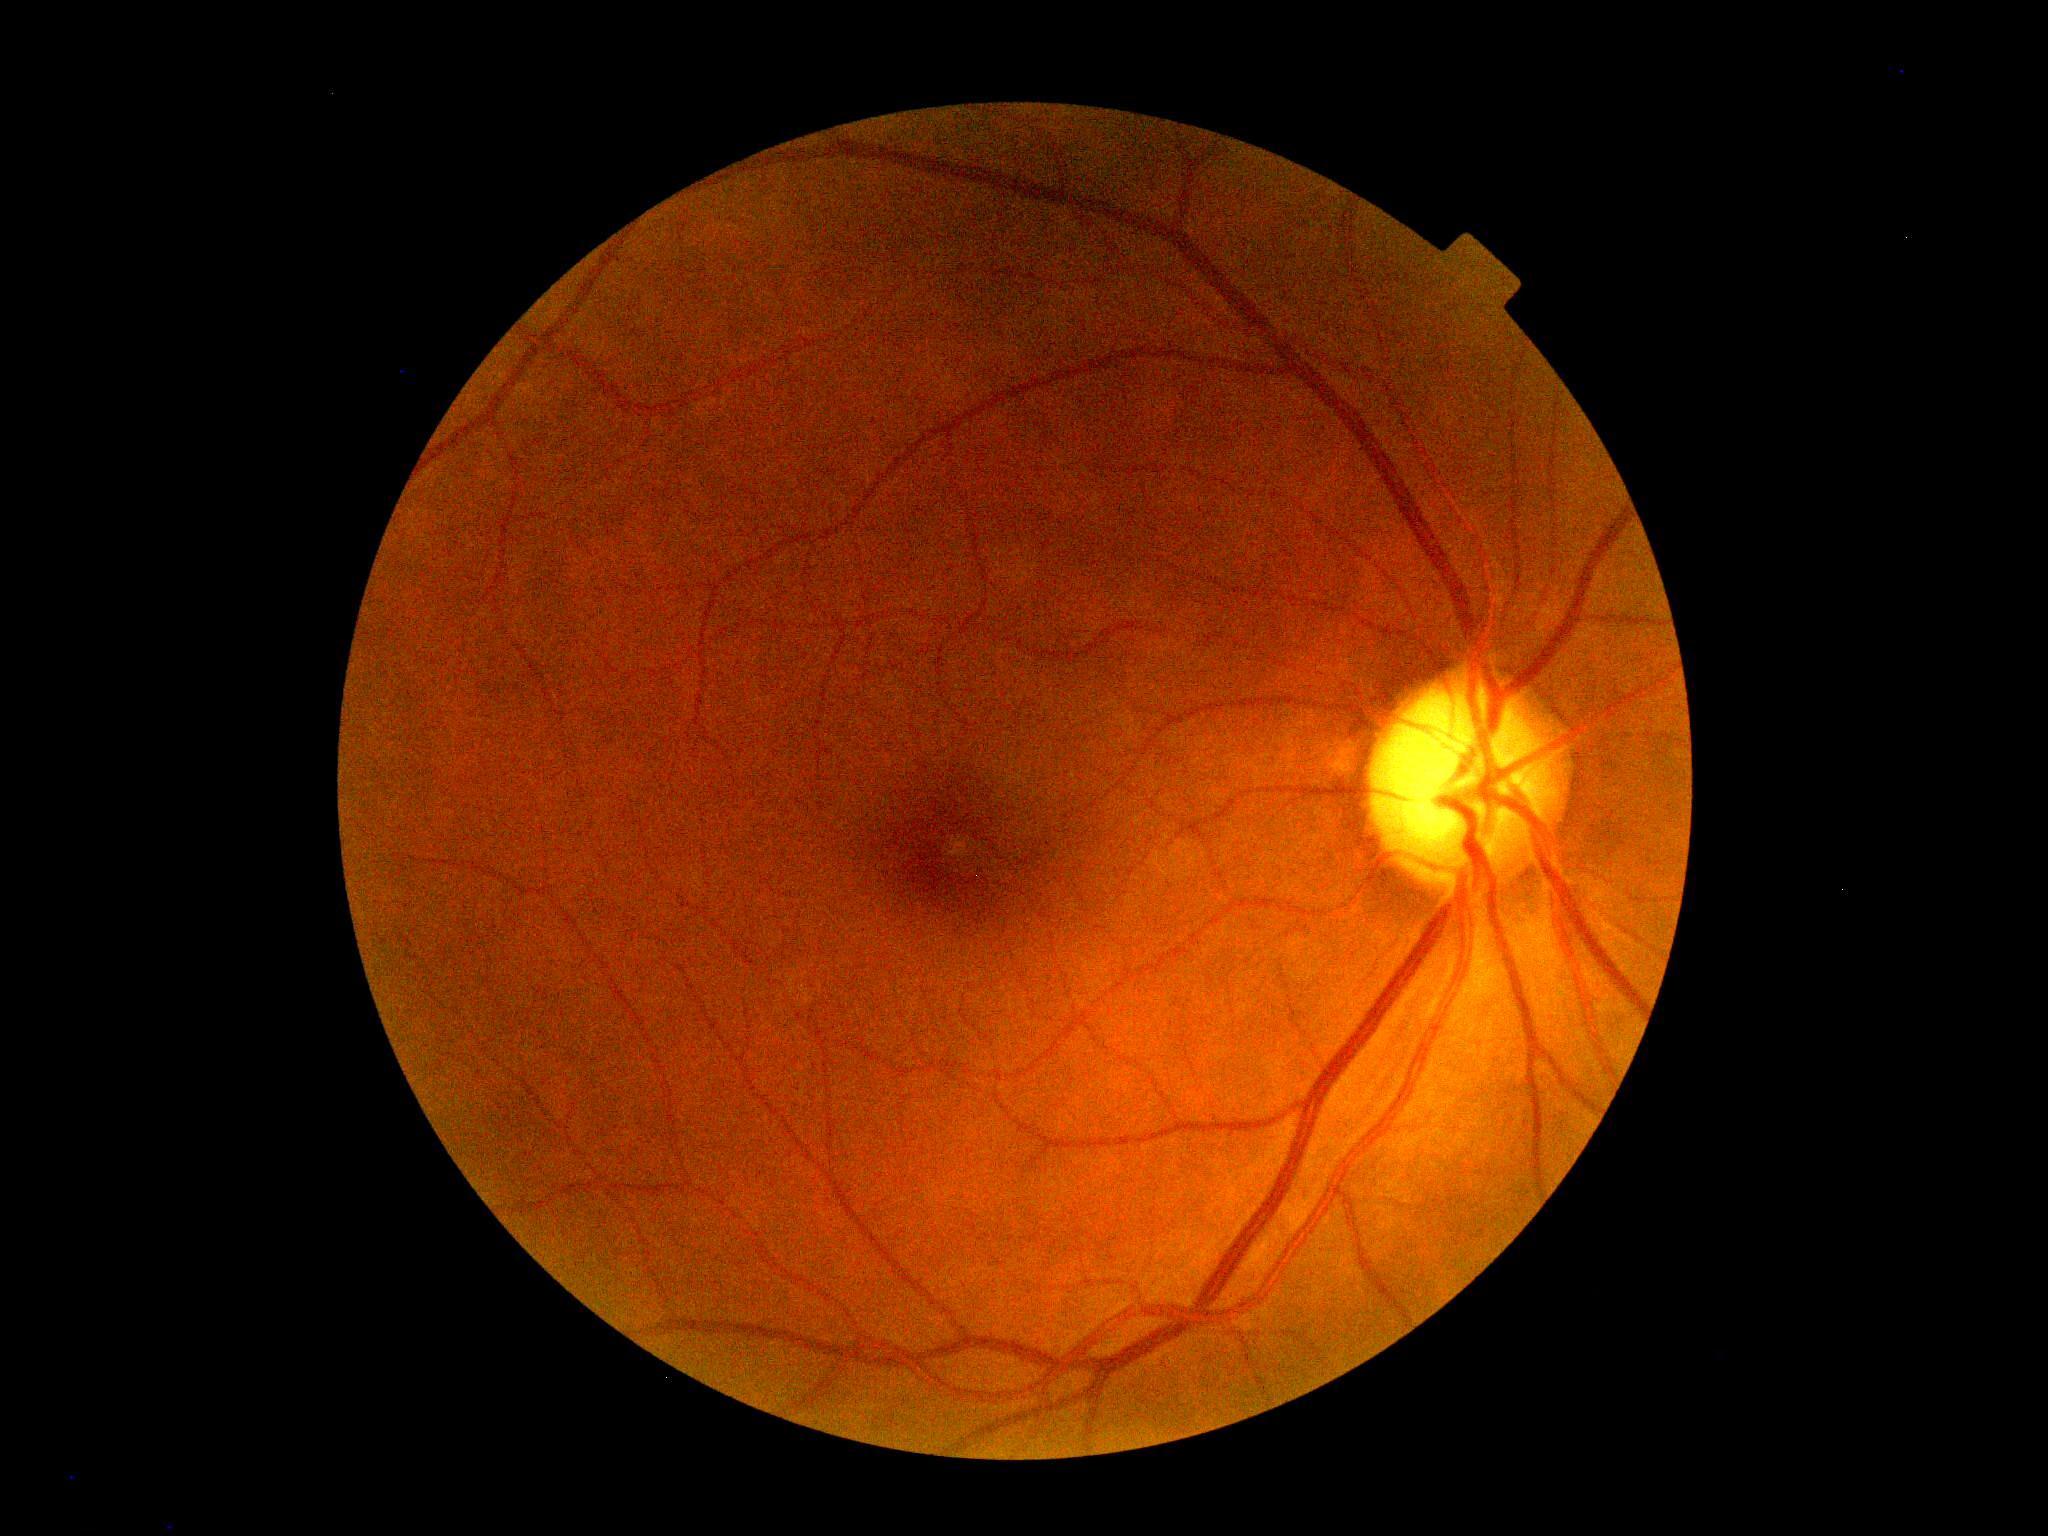
DR severity = 0.